Wide-field fundus photograph of an infant; image size 1440x1080 — 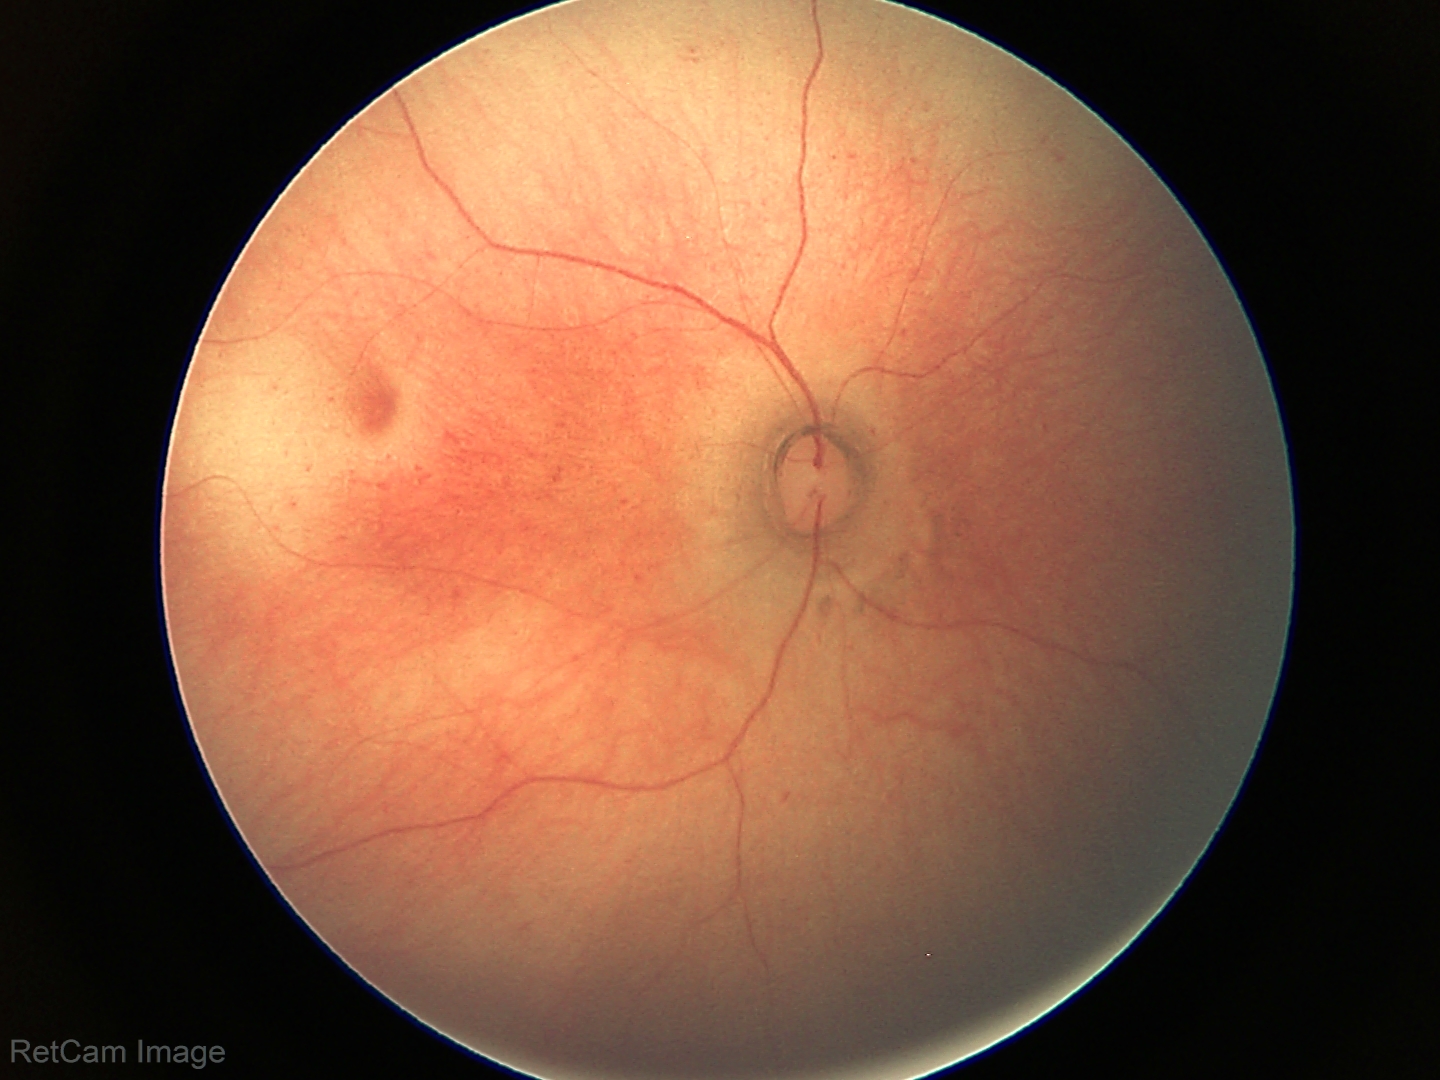
Screening examination with no abnormal retinal findings.